Fundus photo, 2184 by 1690 pixels: 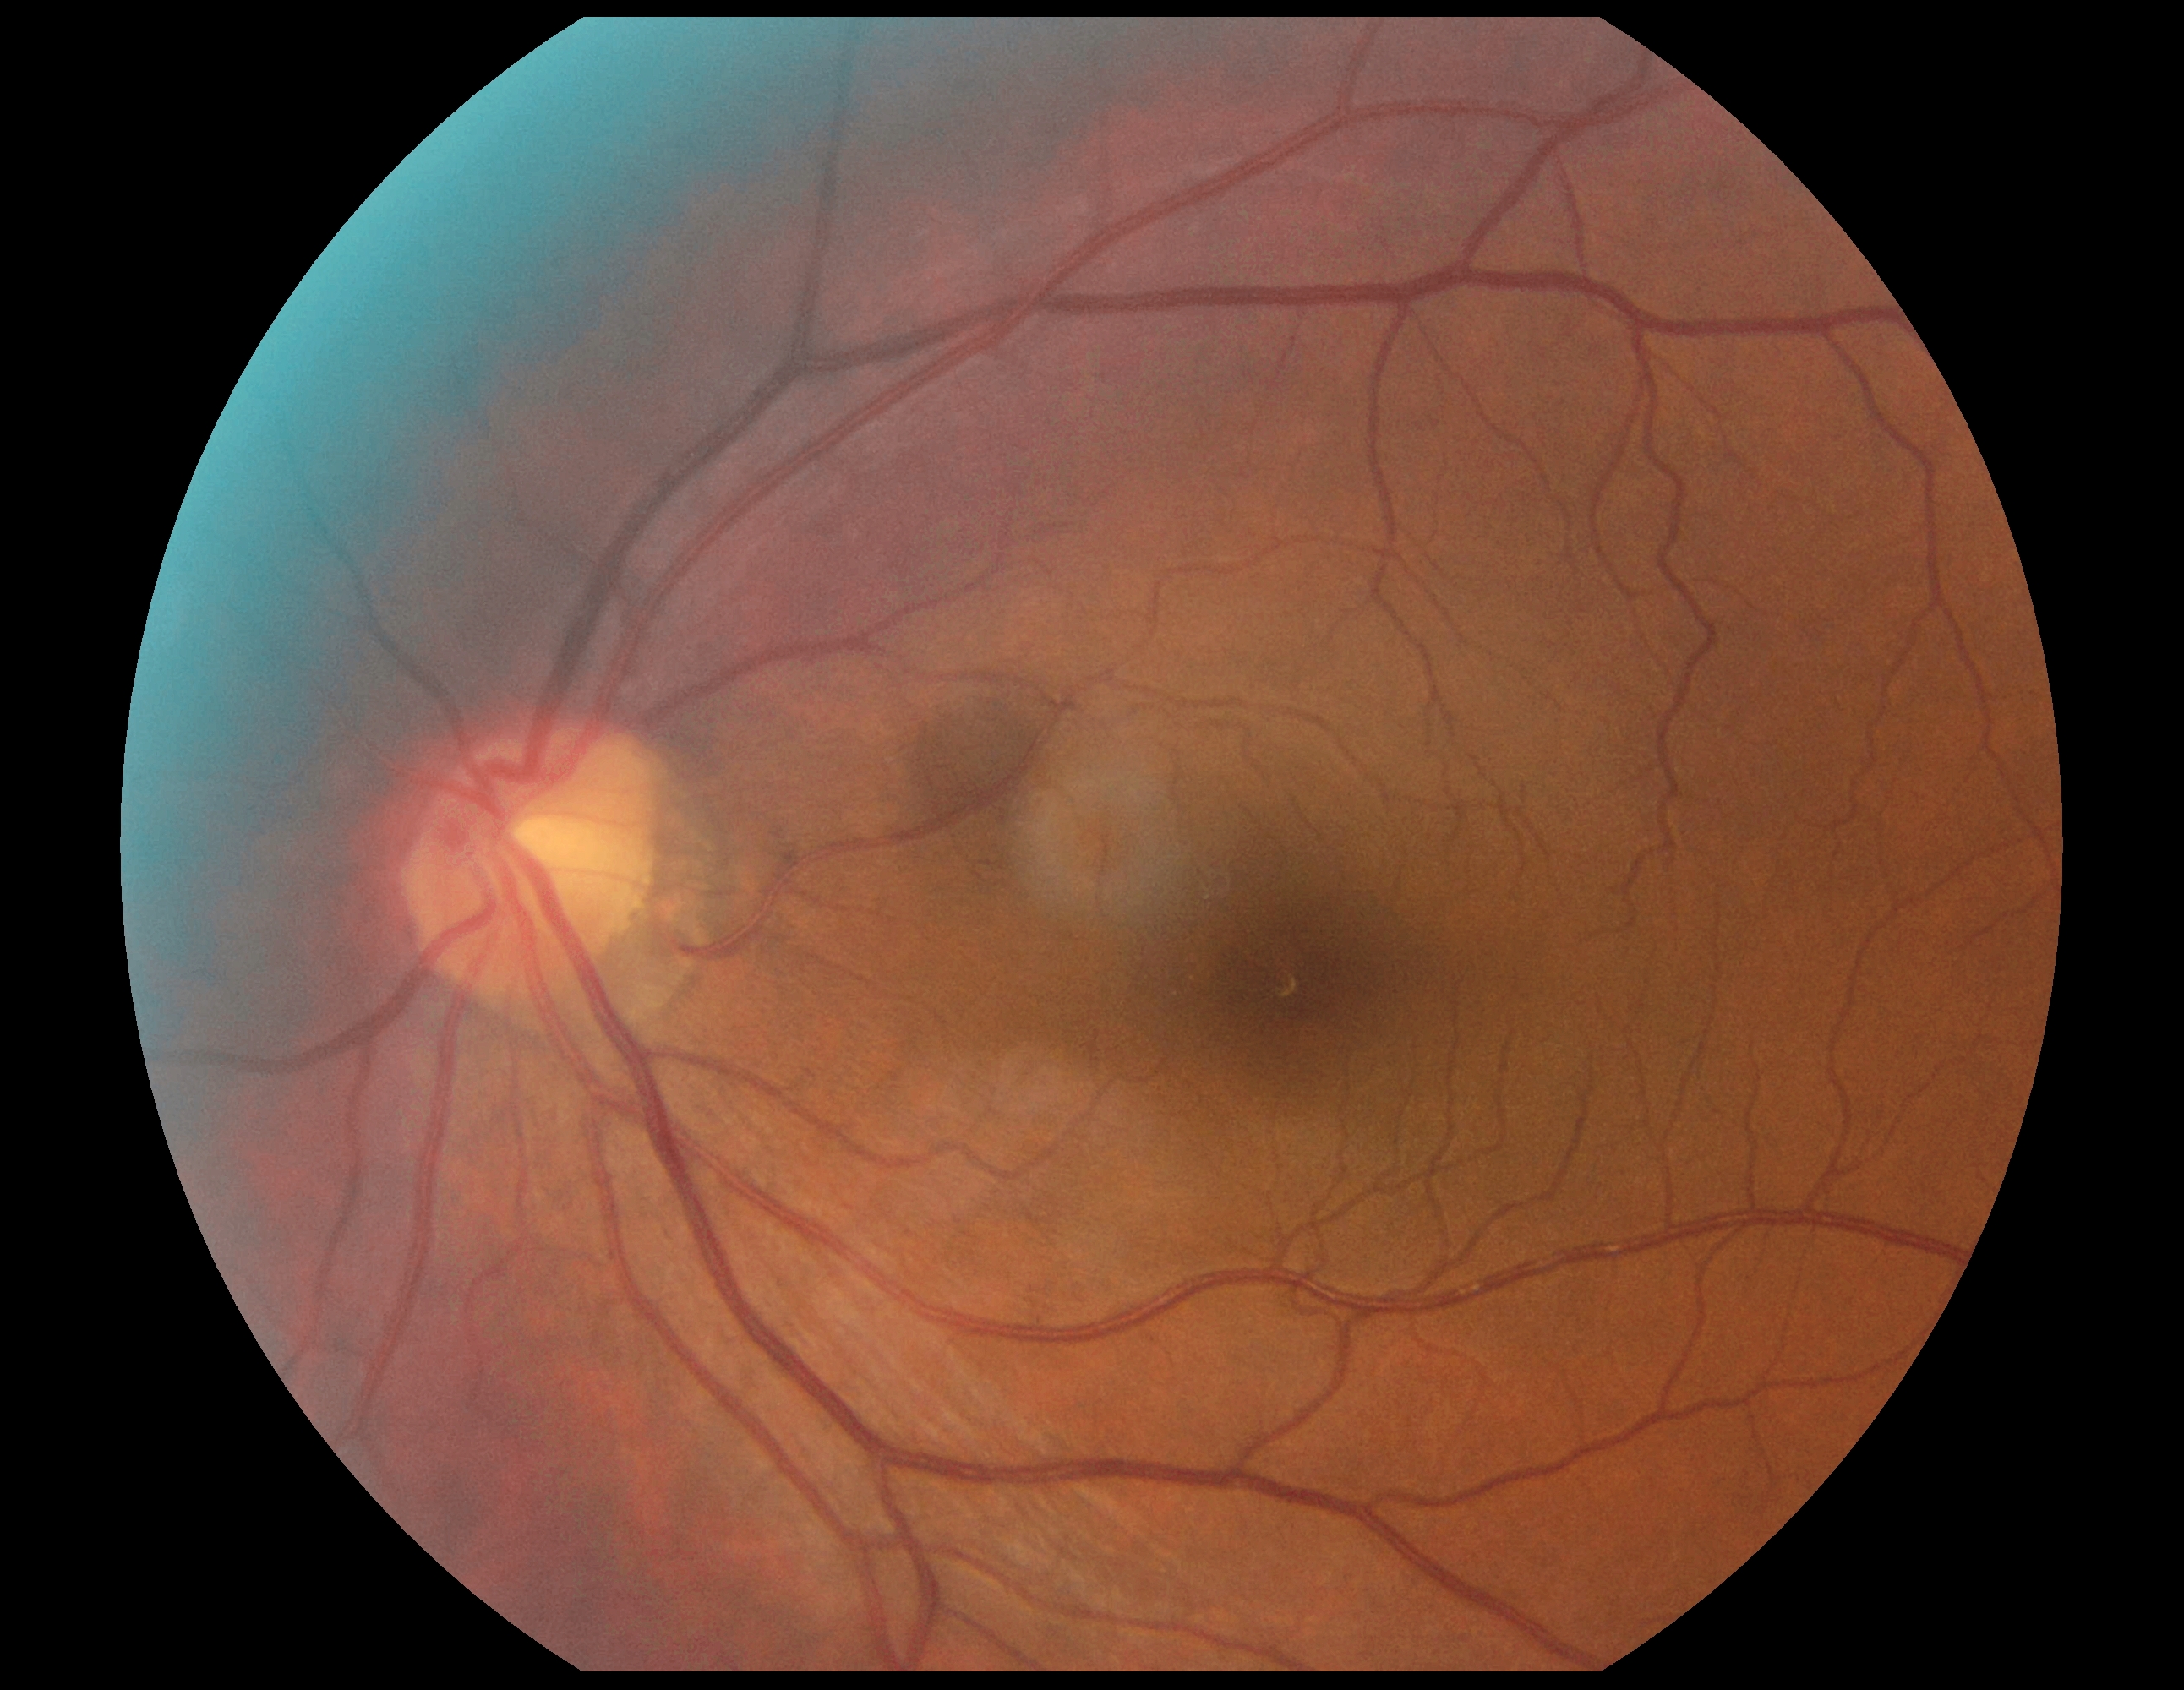 DR stage: 0. No diabetic retinal disease findings.